Retinal fundus photograph. Macula-centered. Image size 1932x1932.
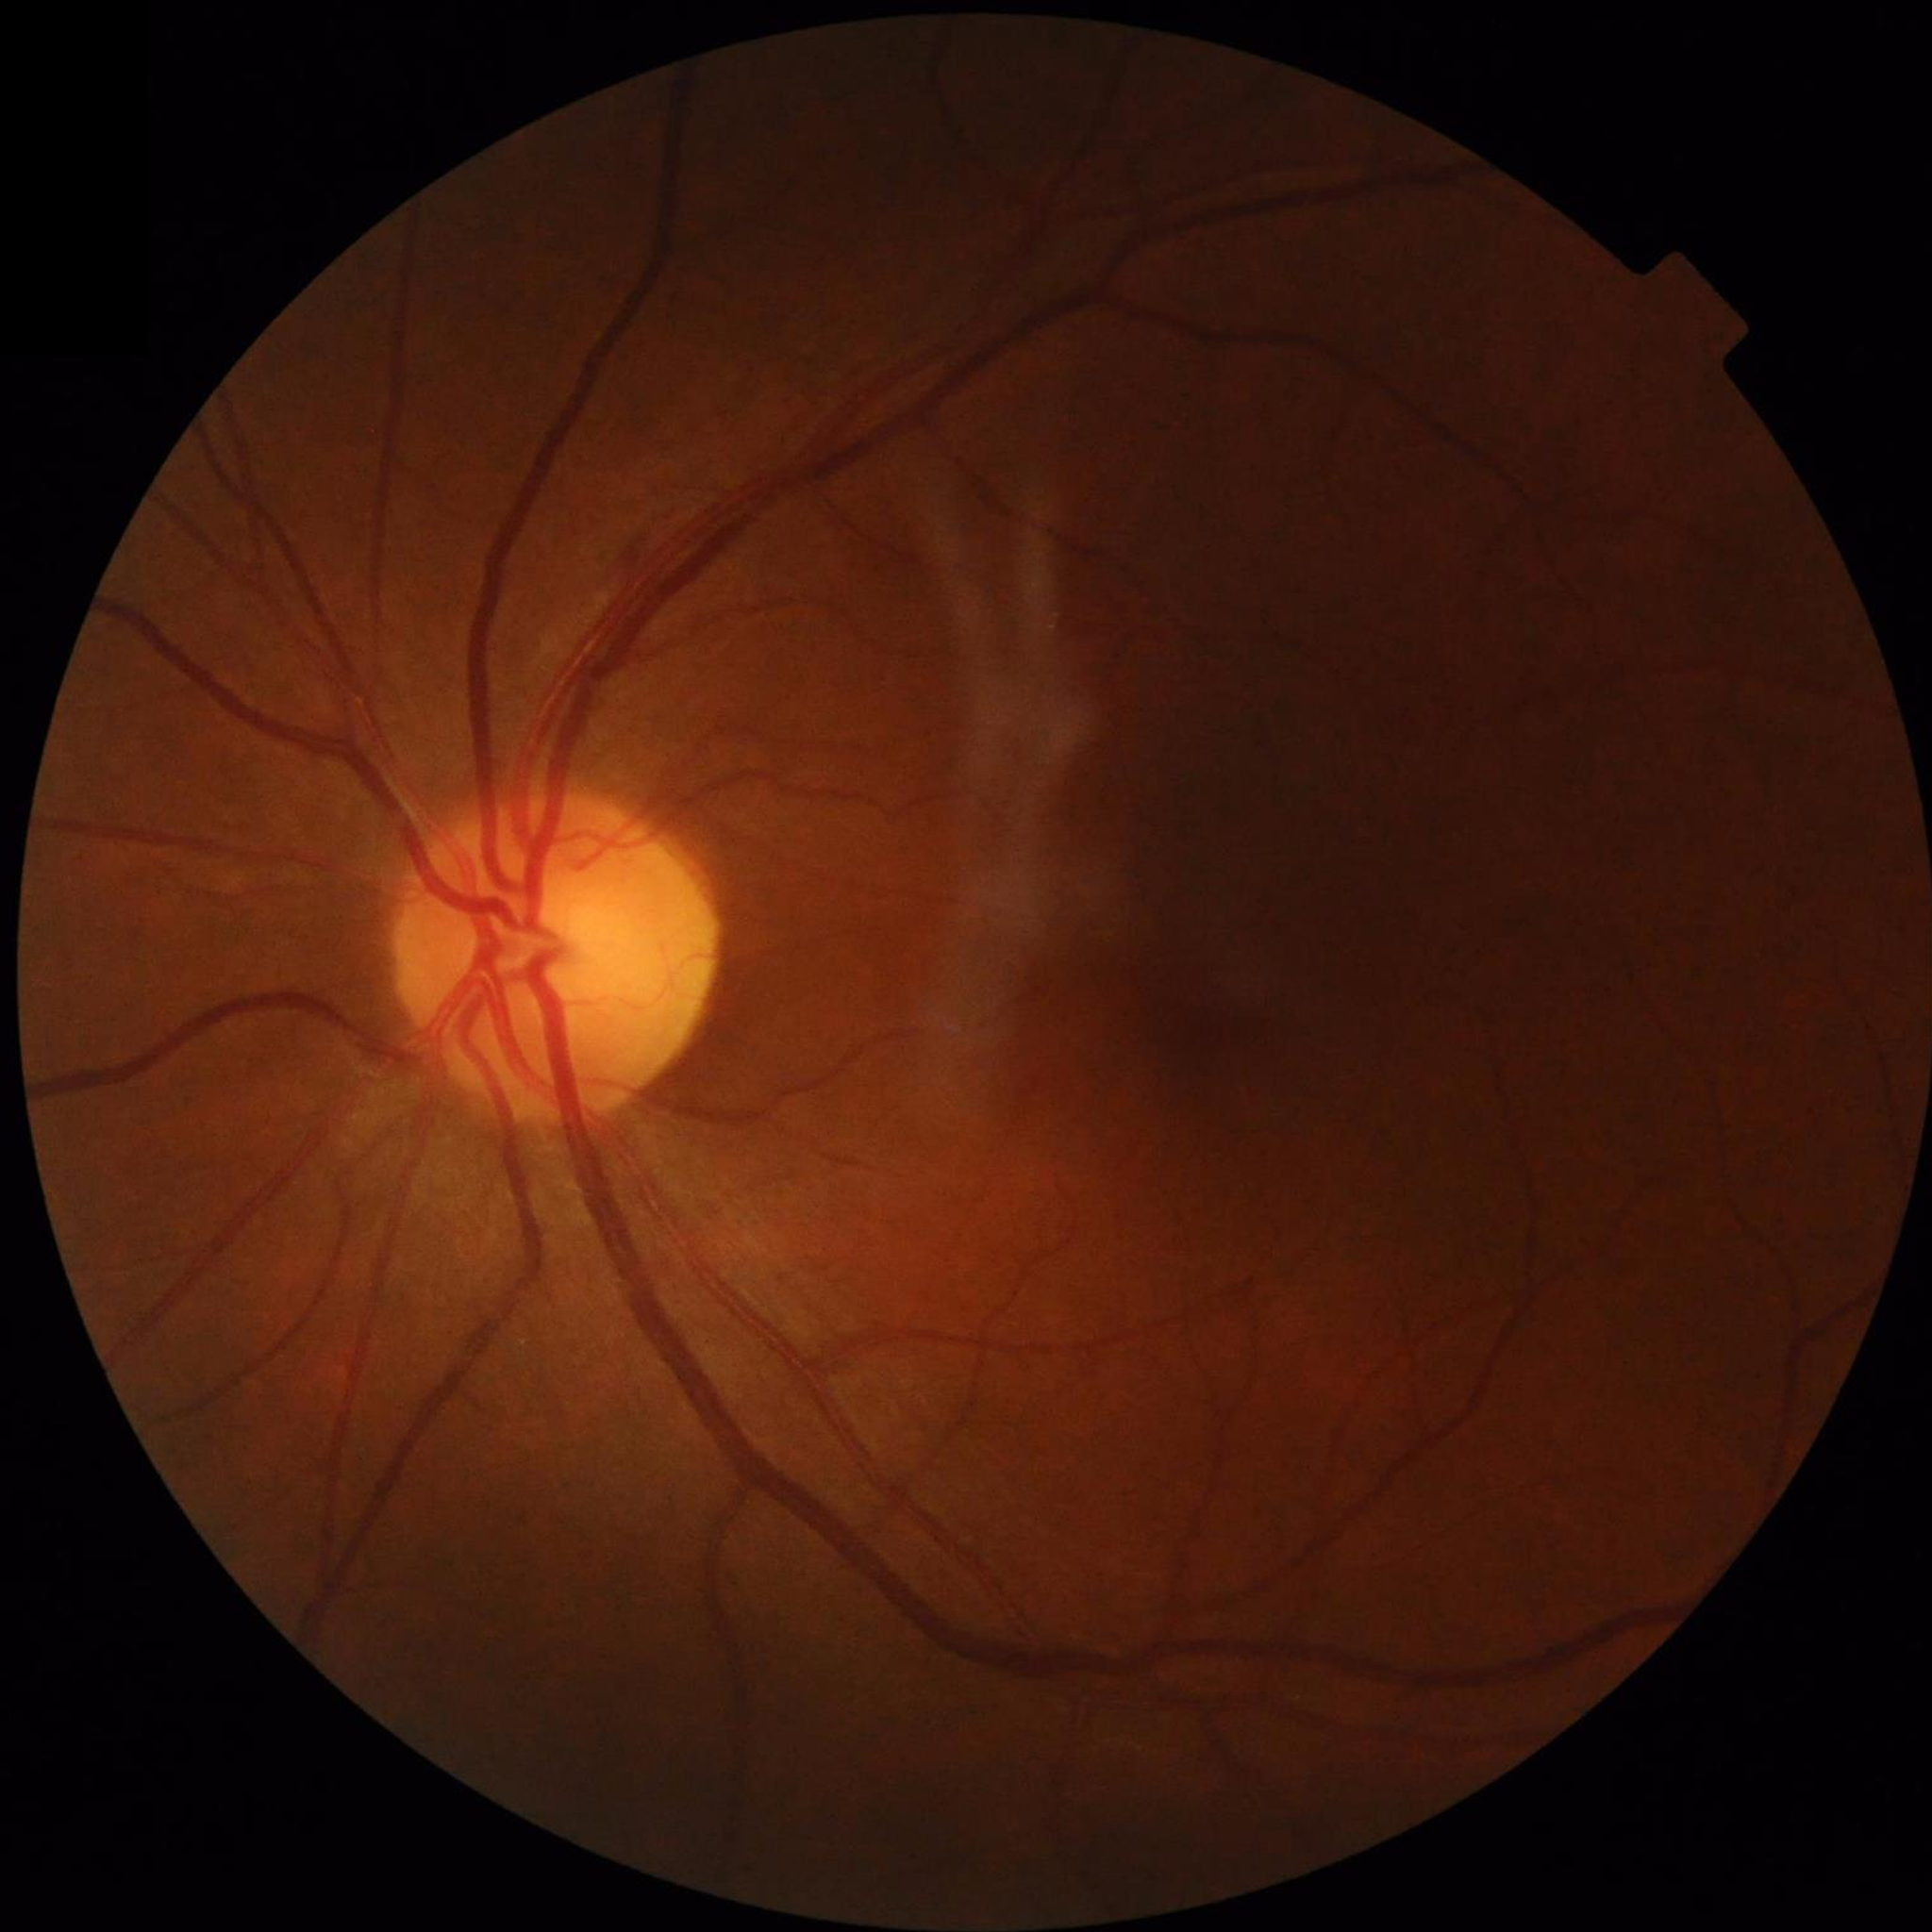

{
  "diagnosis": "no AMD, DR, or glaucoma"
}